45° field of view.
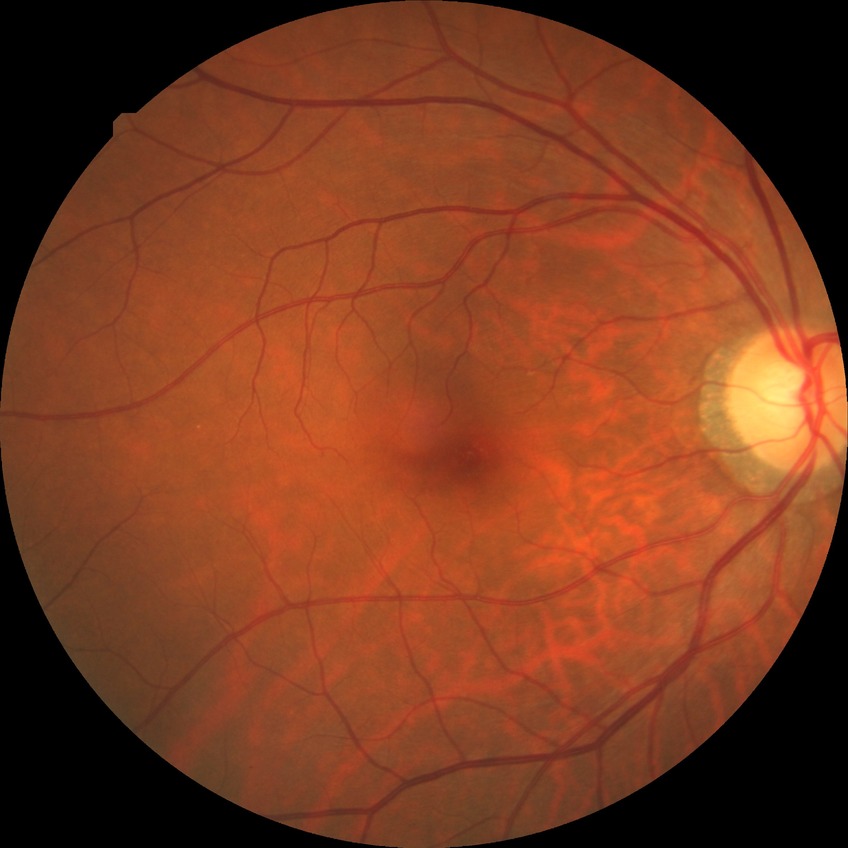

diabetic retinopathy severity: no diabetic retinopathy.